130° field of view (Clarity RetCam 3). Wide-field fundus image from infant ROP screening. 640x480px — 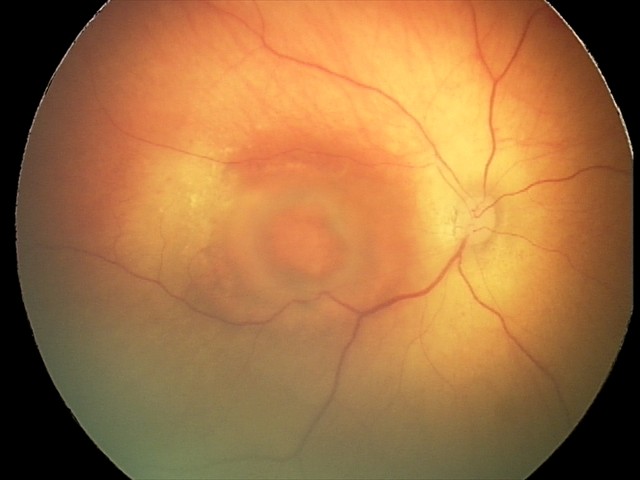

Finding: toxoplasmosis chorioretinitis.